Captured on a Topcon TRC-50DX fundus camera:
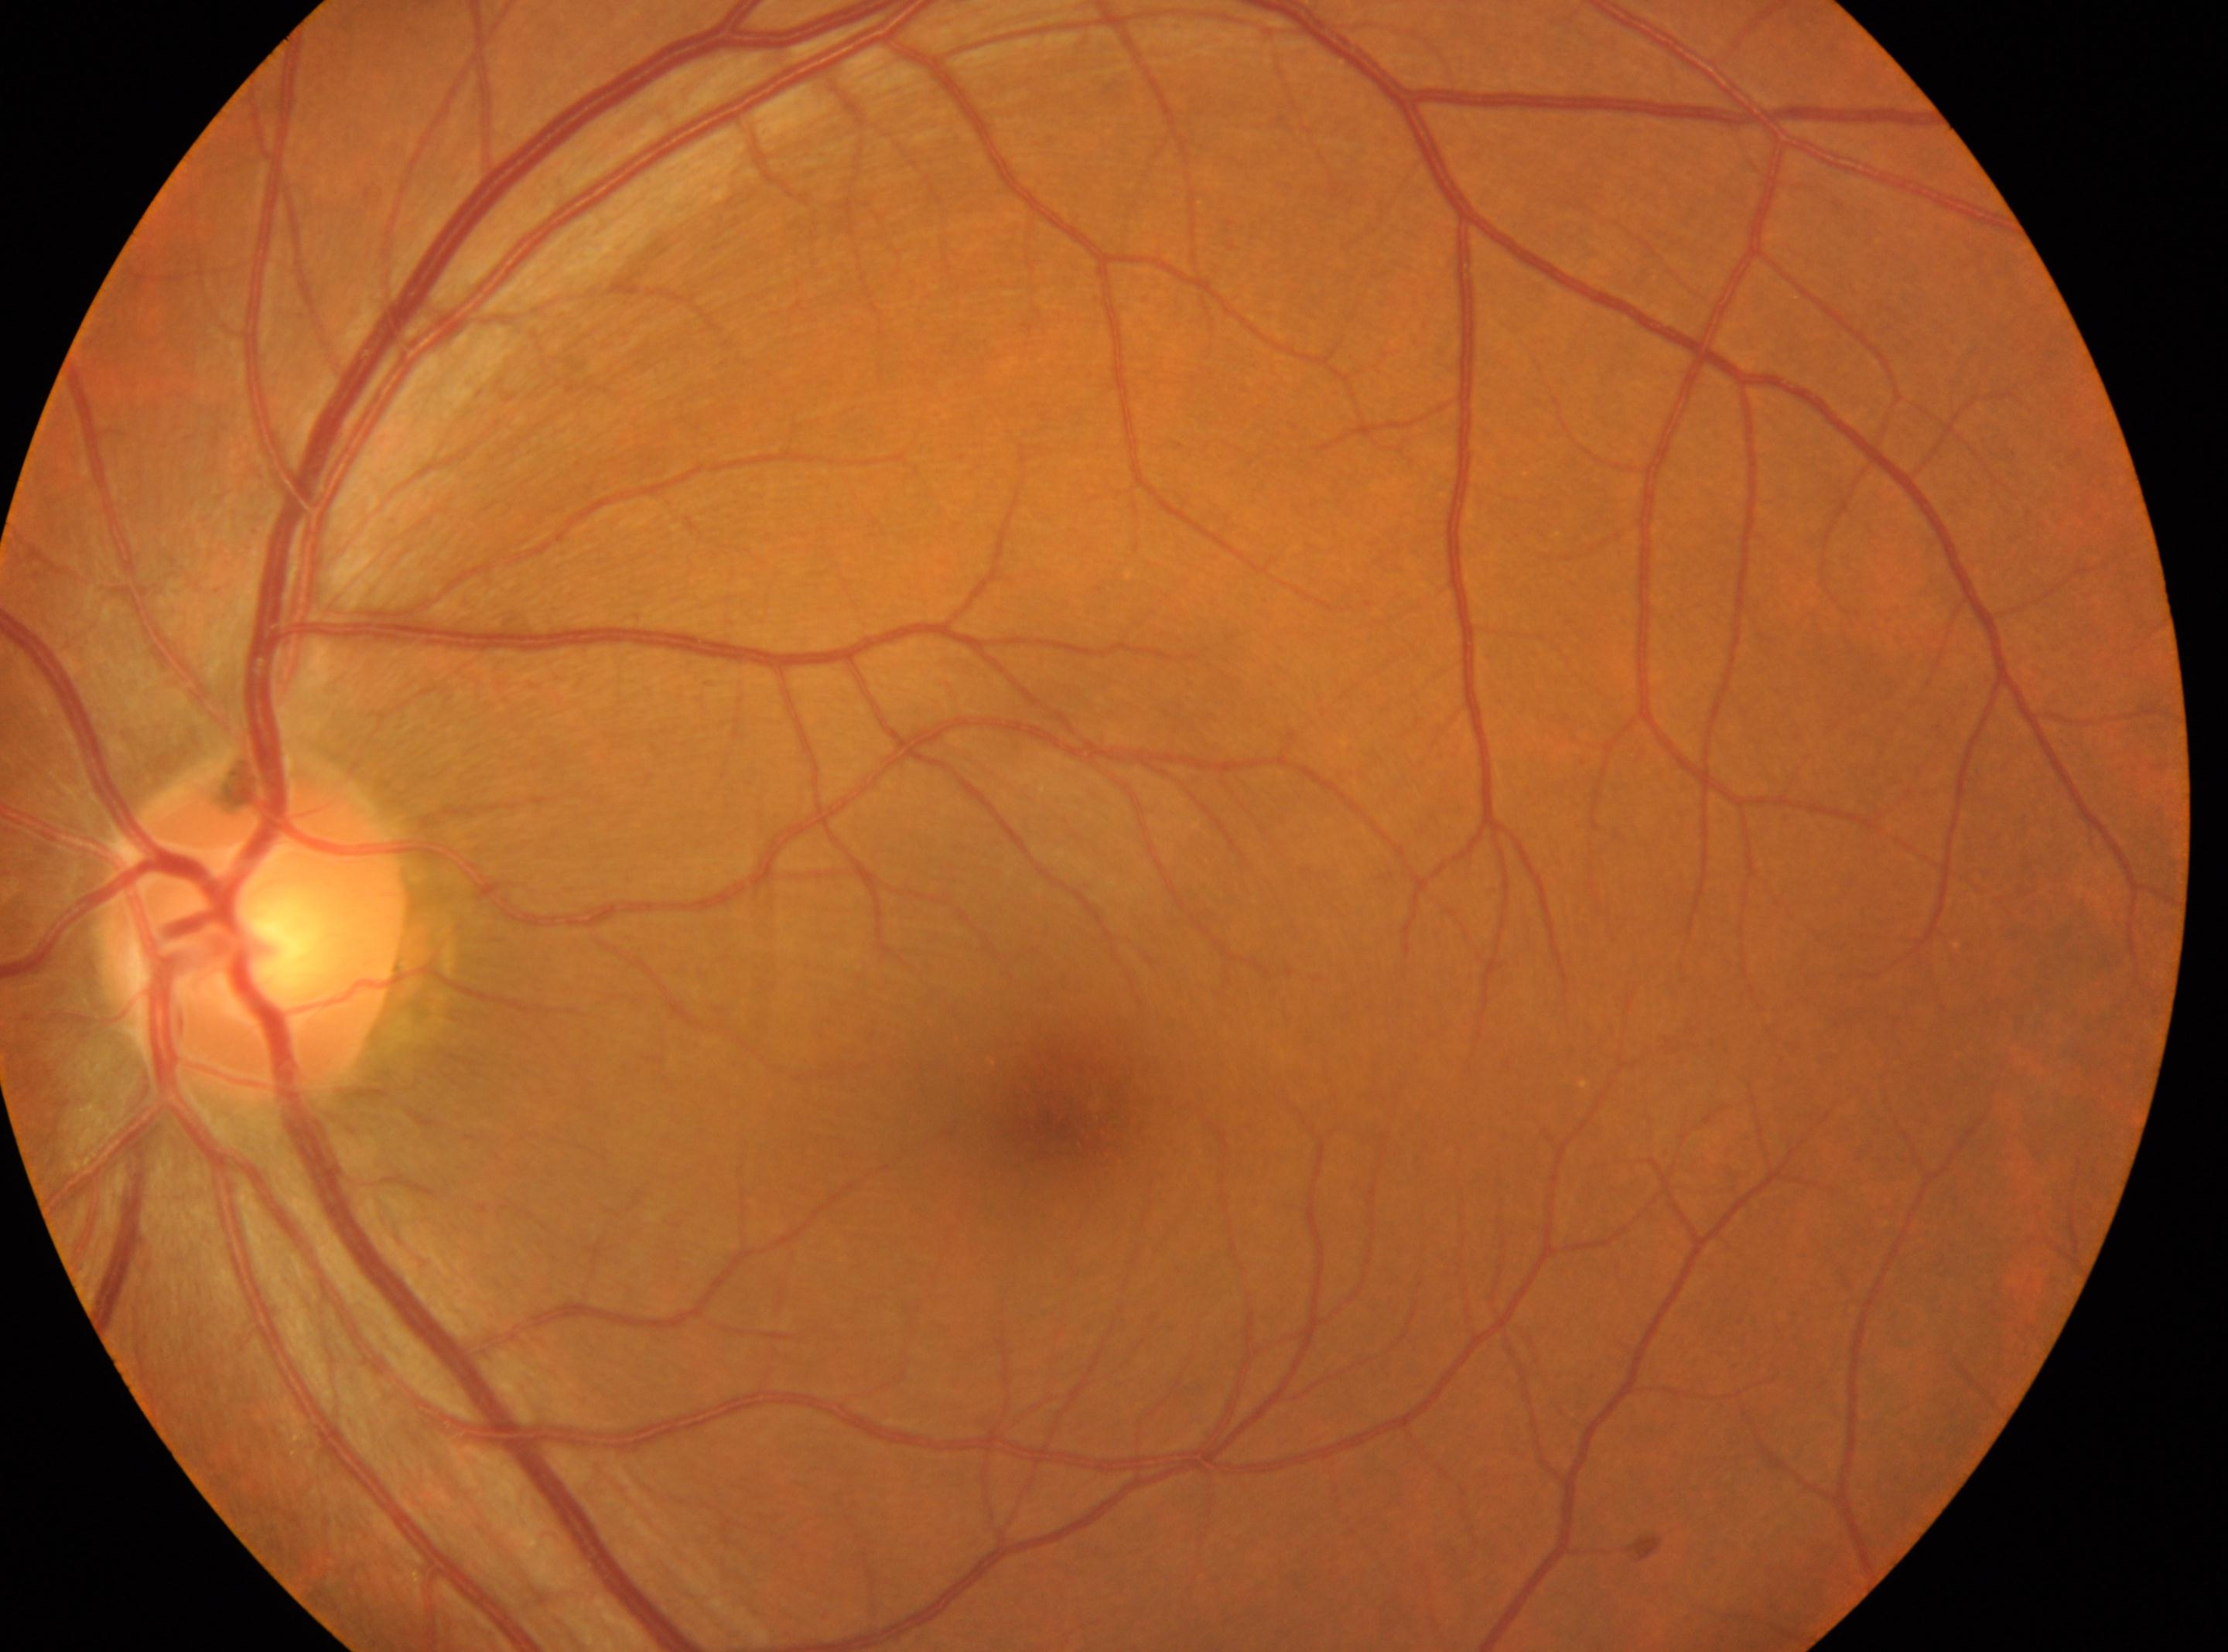

This is the OS.
Diabetic retinopathy severity: no apparent diabetic retinopathy (grade 0).
ONH: (x=252, y=923).
Fovea located at (x=1054, y=1108).